Color fundus image · 2352 by 1568 pixels:
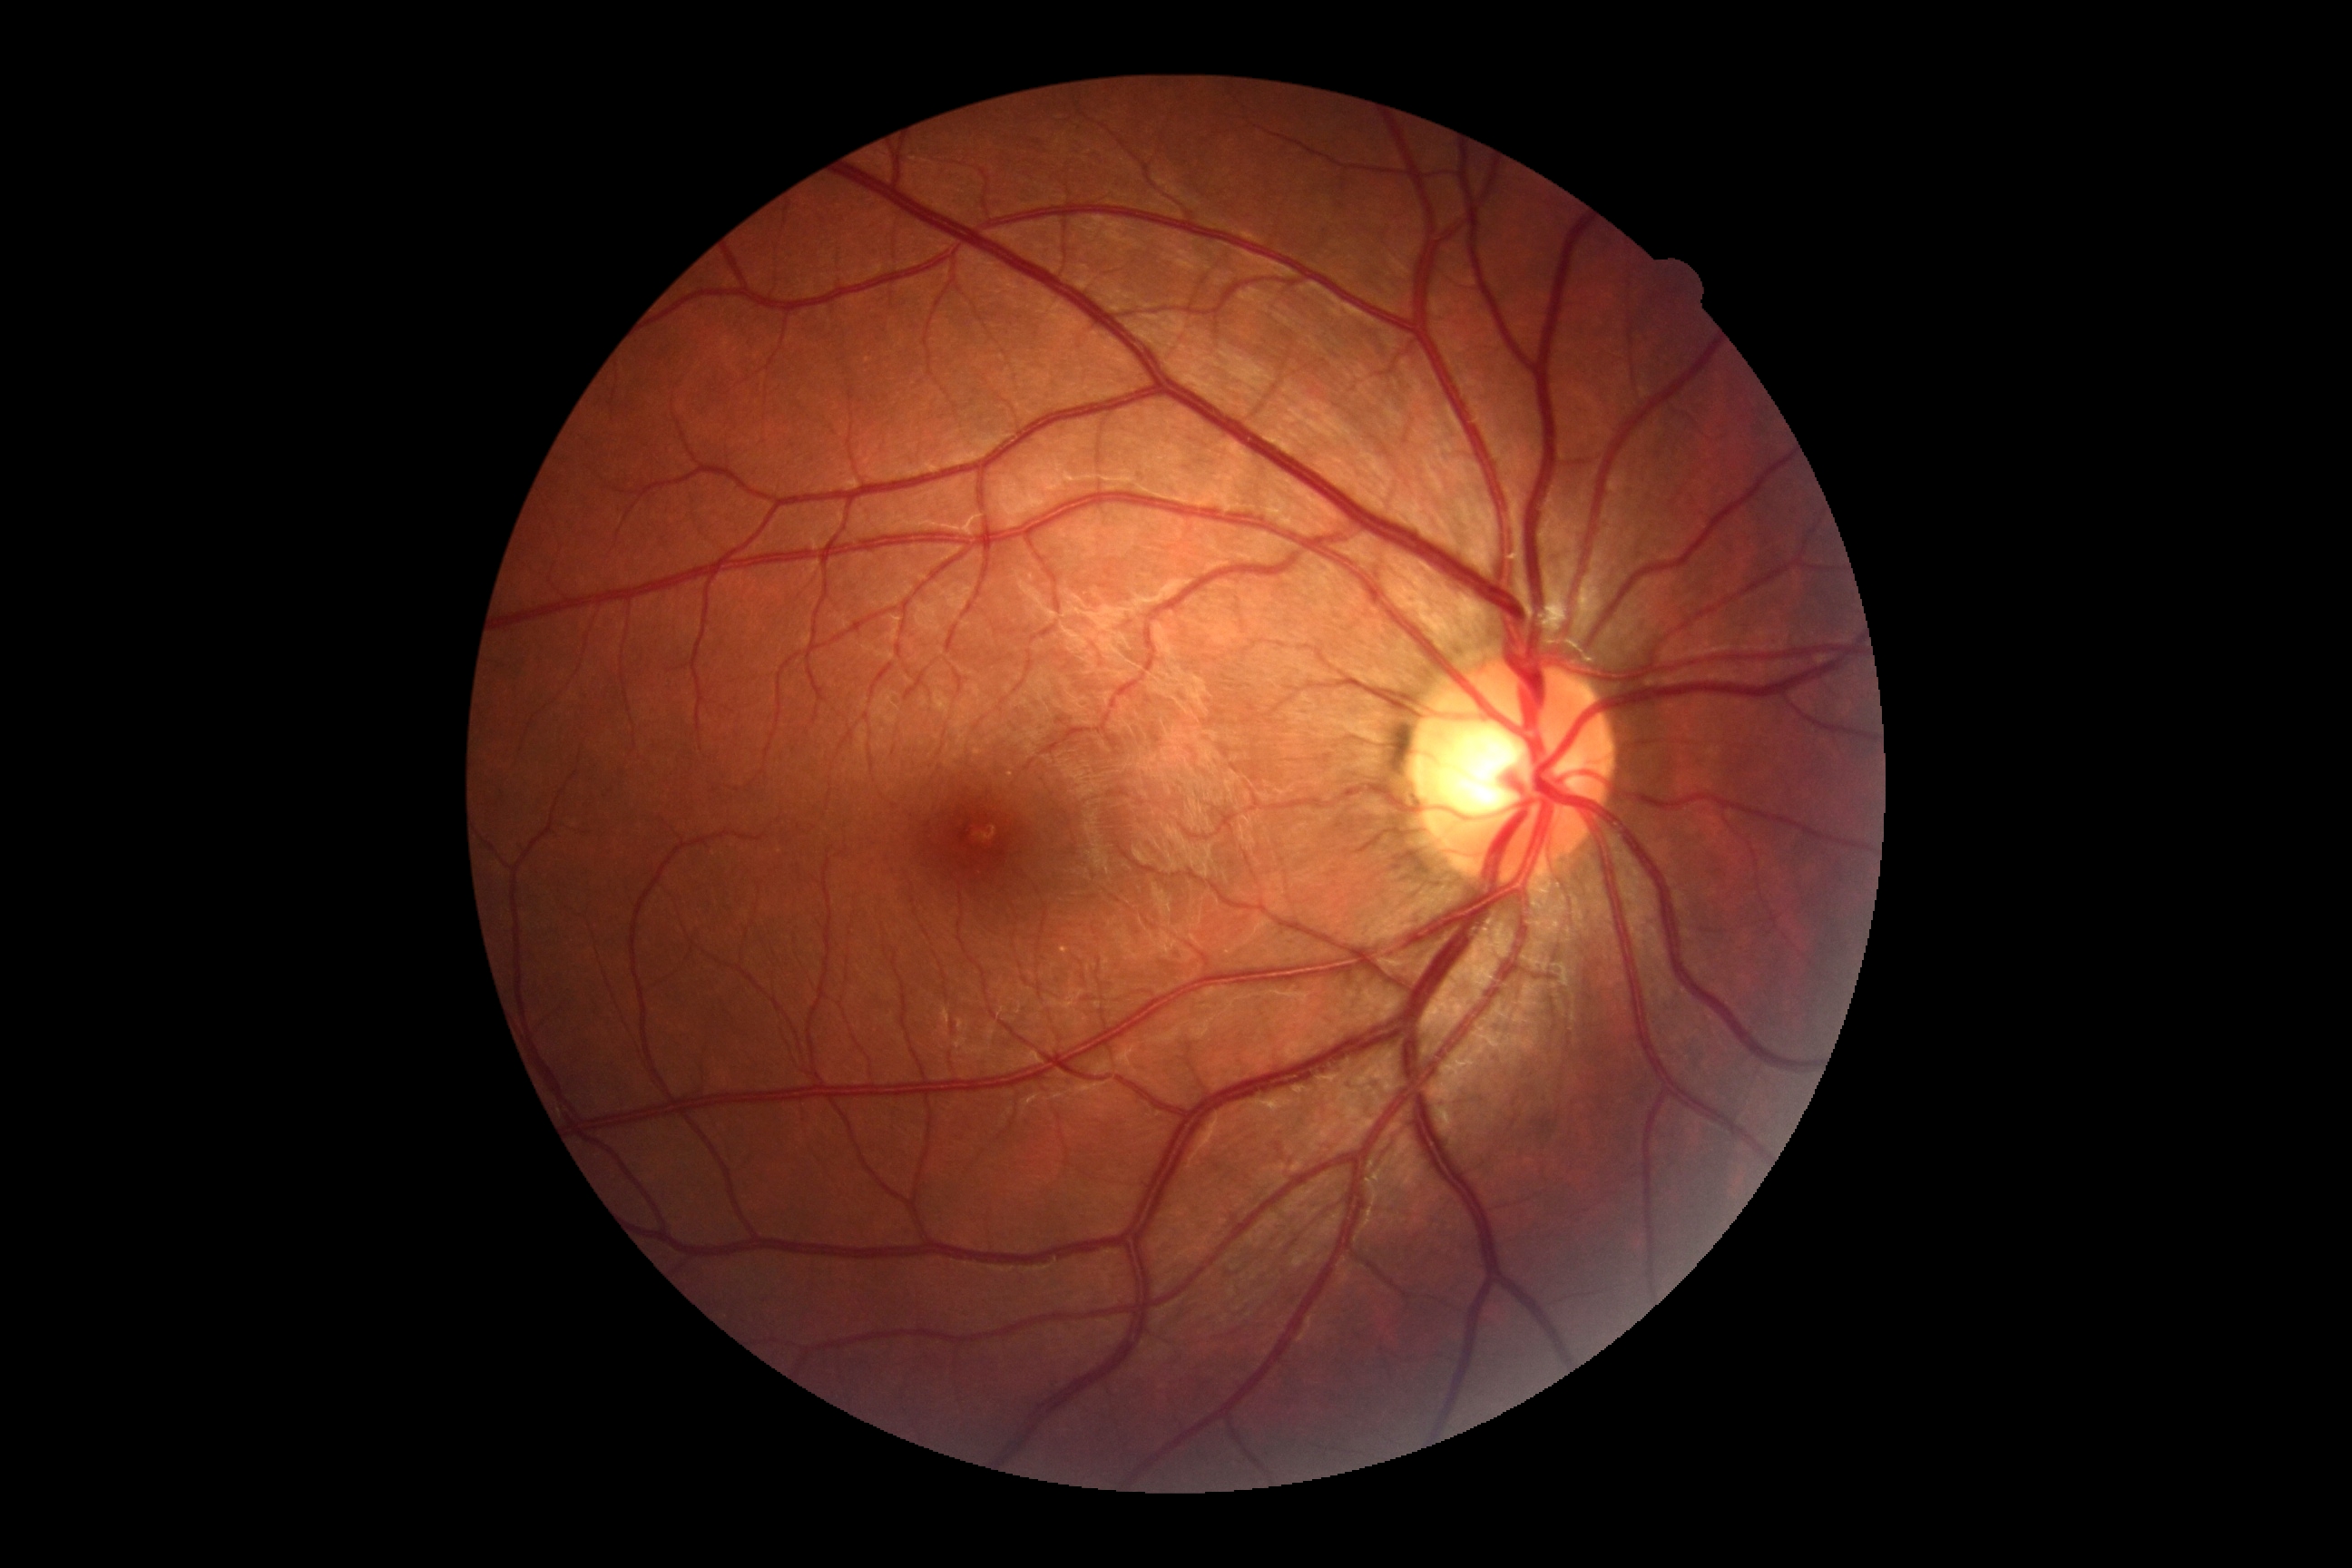
Diabetic retinopathy (DR) is grade 0.